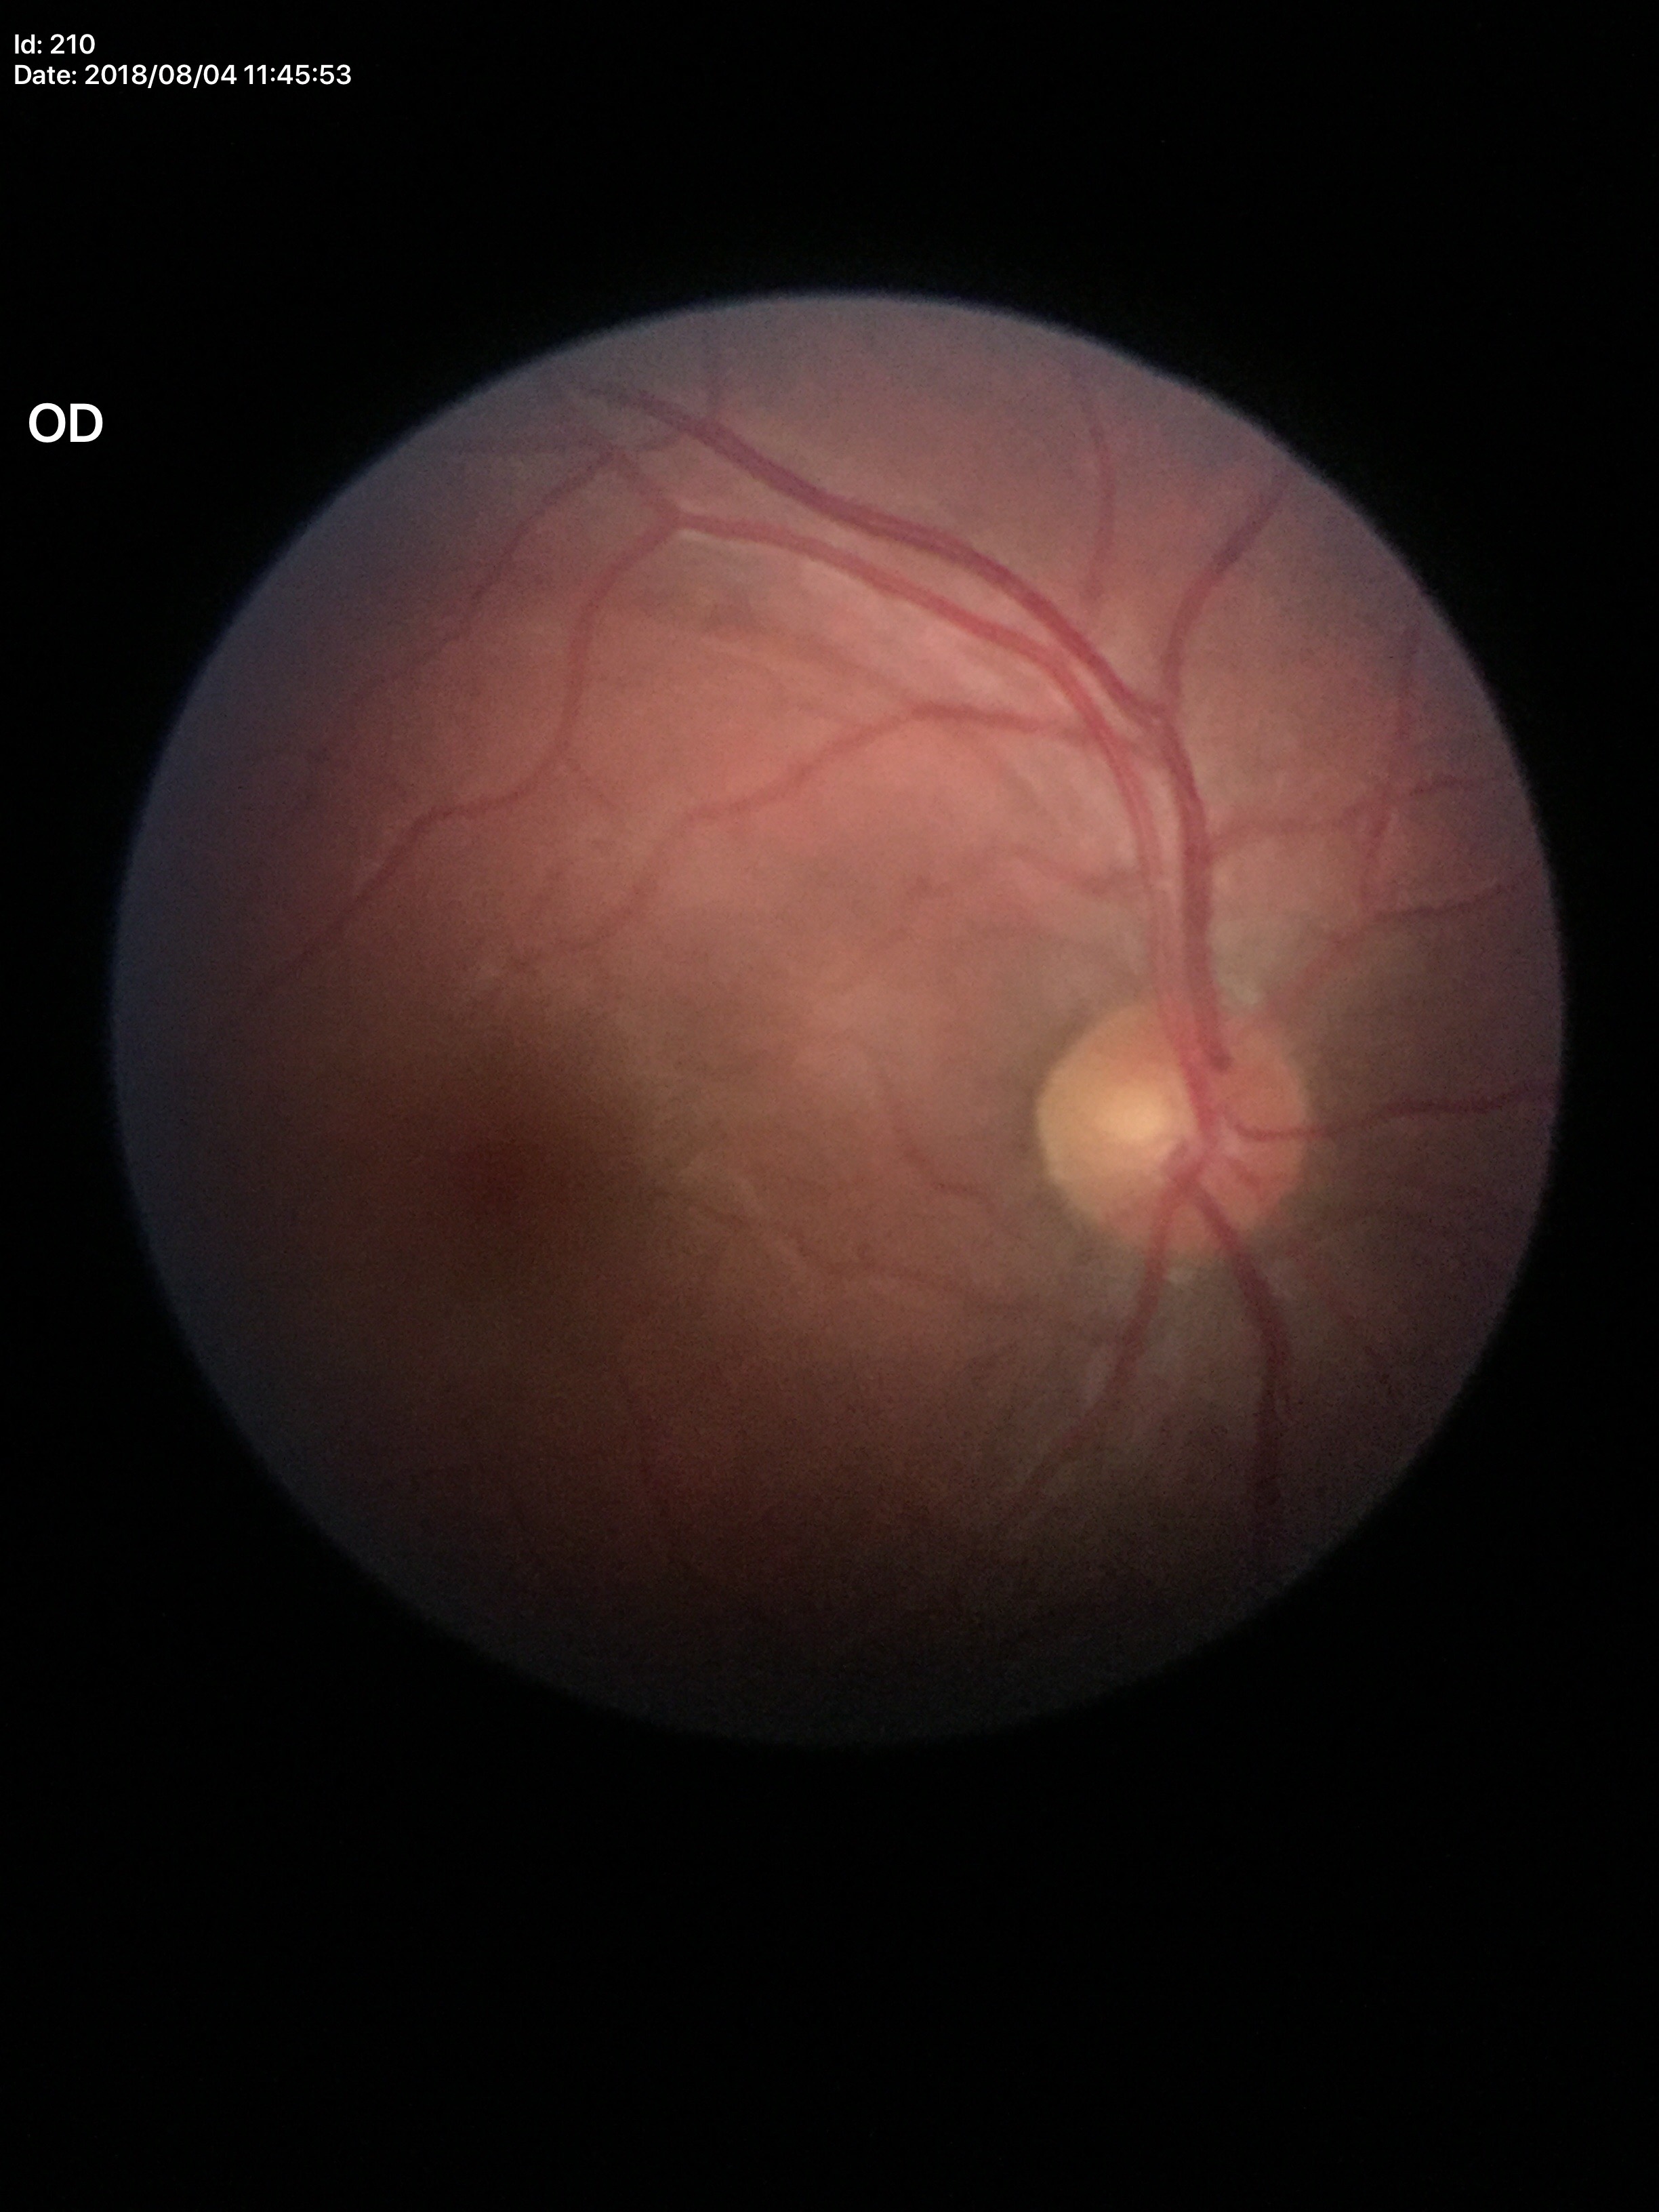 Area C/D ratio (ACDR) is 0.23. Vertical CDR (VCDR): 0.47. Glaucoma impression: negative.